Modified Davis classification · 45° field of view
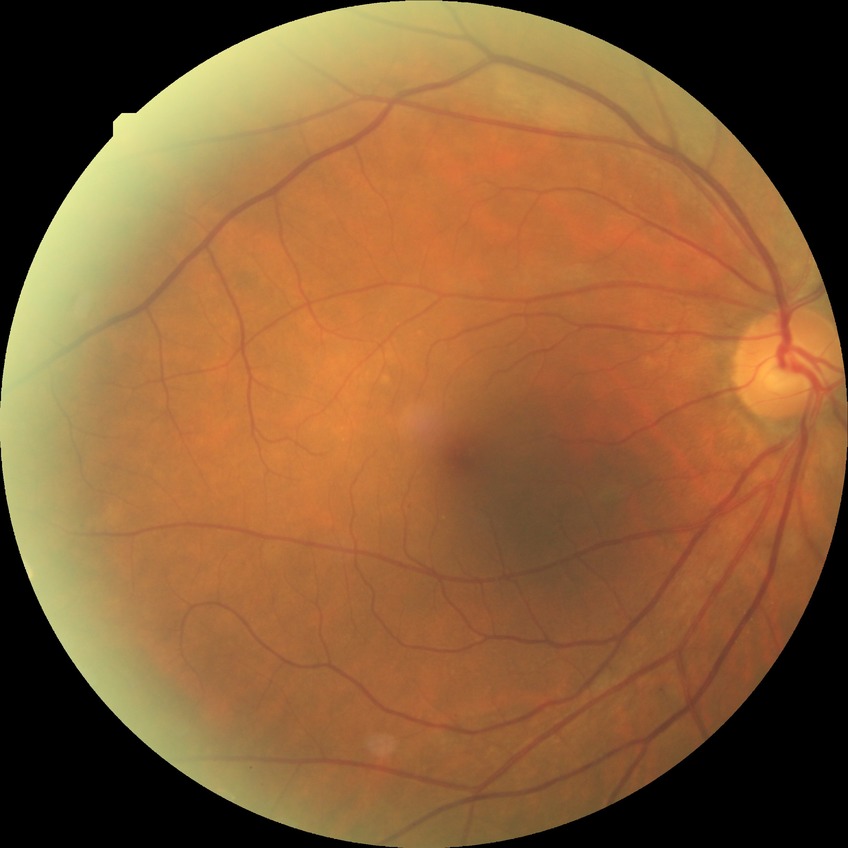 Modified Davis grading: no diabetic retinopathy.